Gender: F · autorefraction: -0.75 -0.5 × 143° · acquired with a Topcon TRC-NW400 · axial length (AL) 25.01 mm · pachymetry: 482 µm
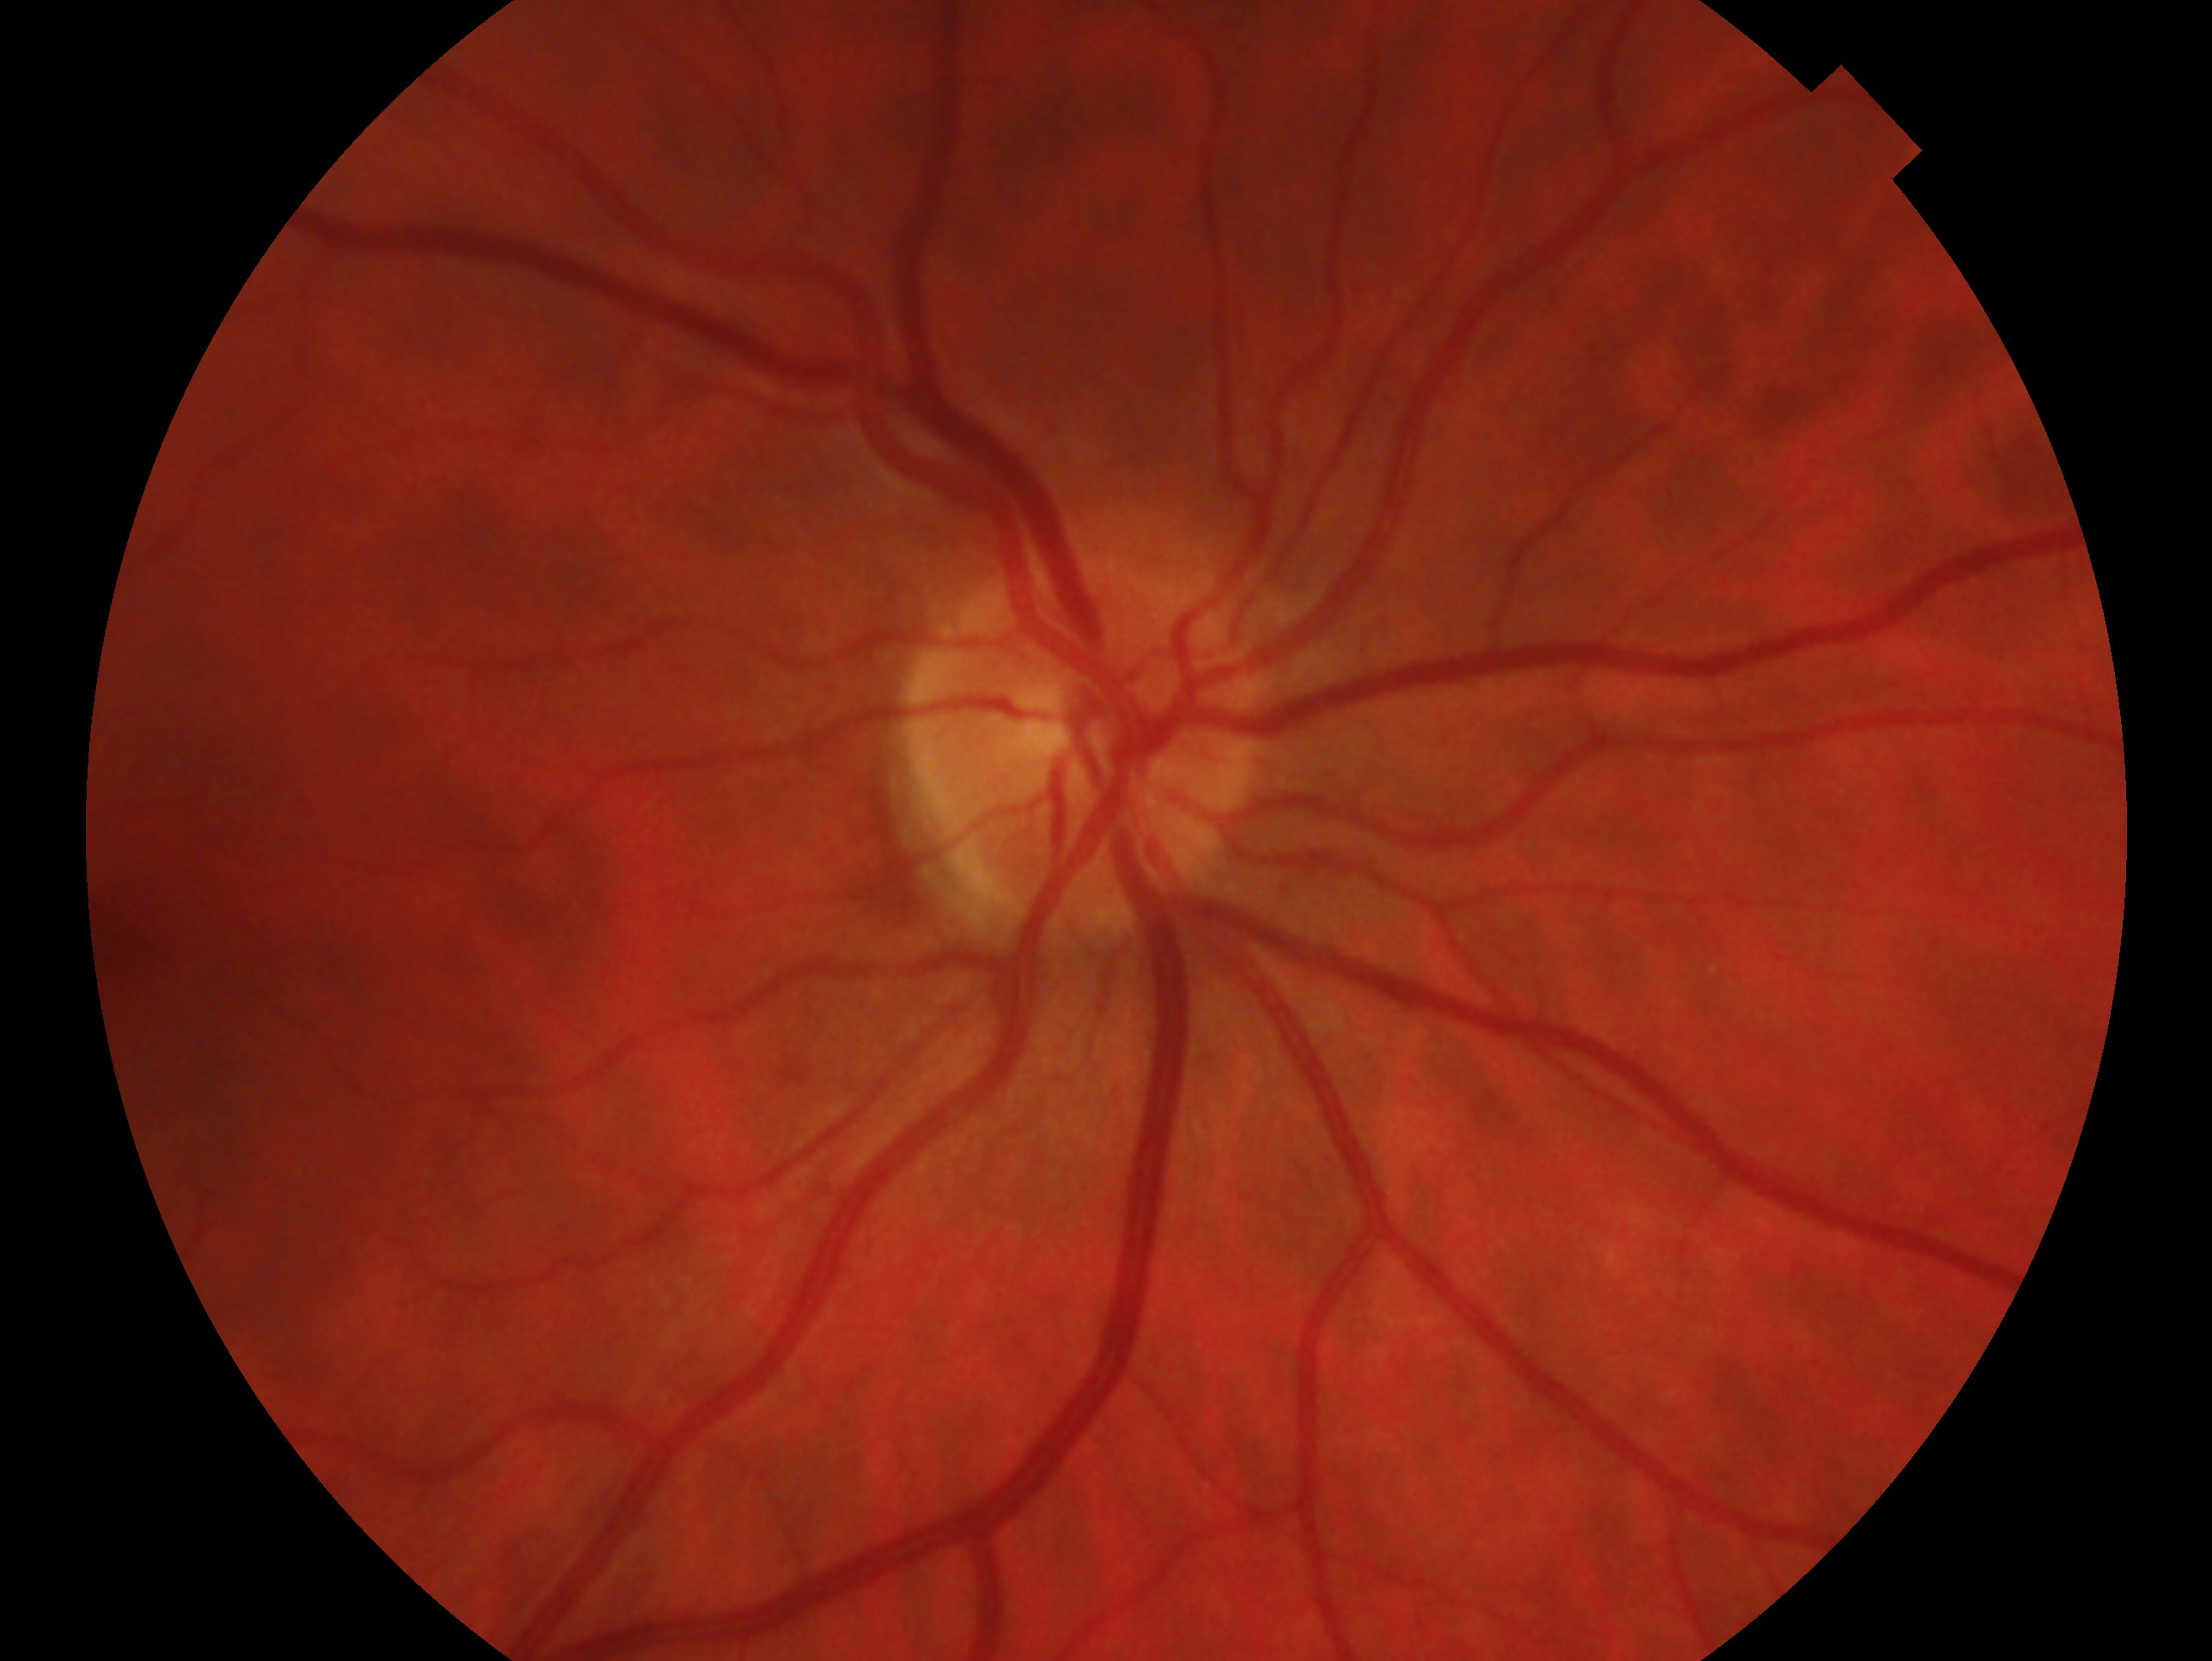
The image shows the right eye. Glaucoma diagnosis: no glaucoma — no clinical evidence of glaucoma in this eye.